848x848px; 45-degree field of view; nonmydriatic fundus photograph
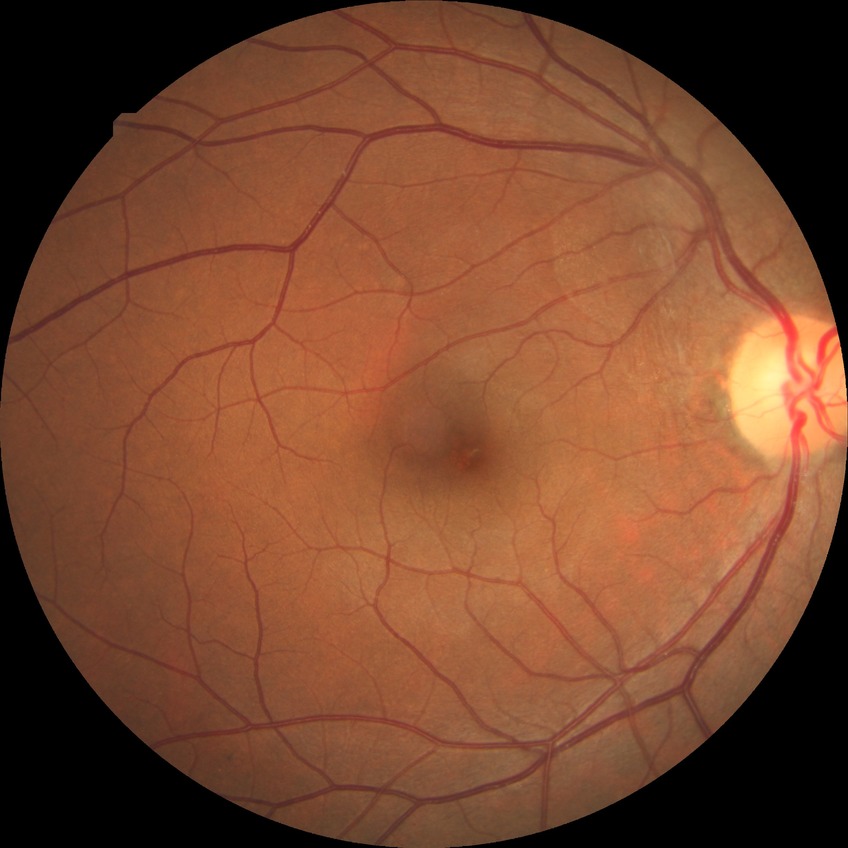

Annotations:
• retinopathy grade: no diabetic retinopathy